2352x1568px; 45-degree field of view
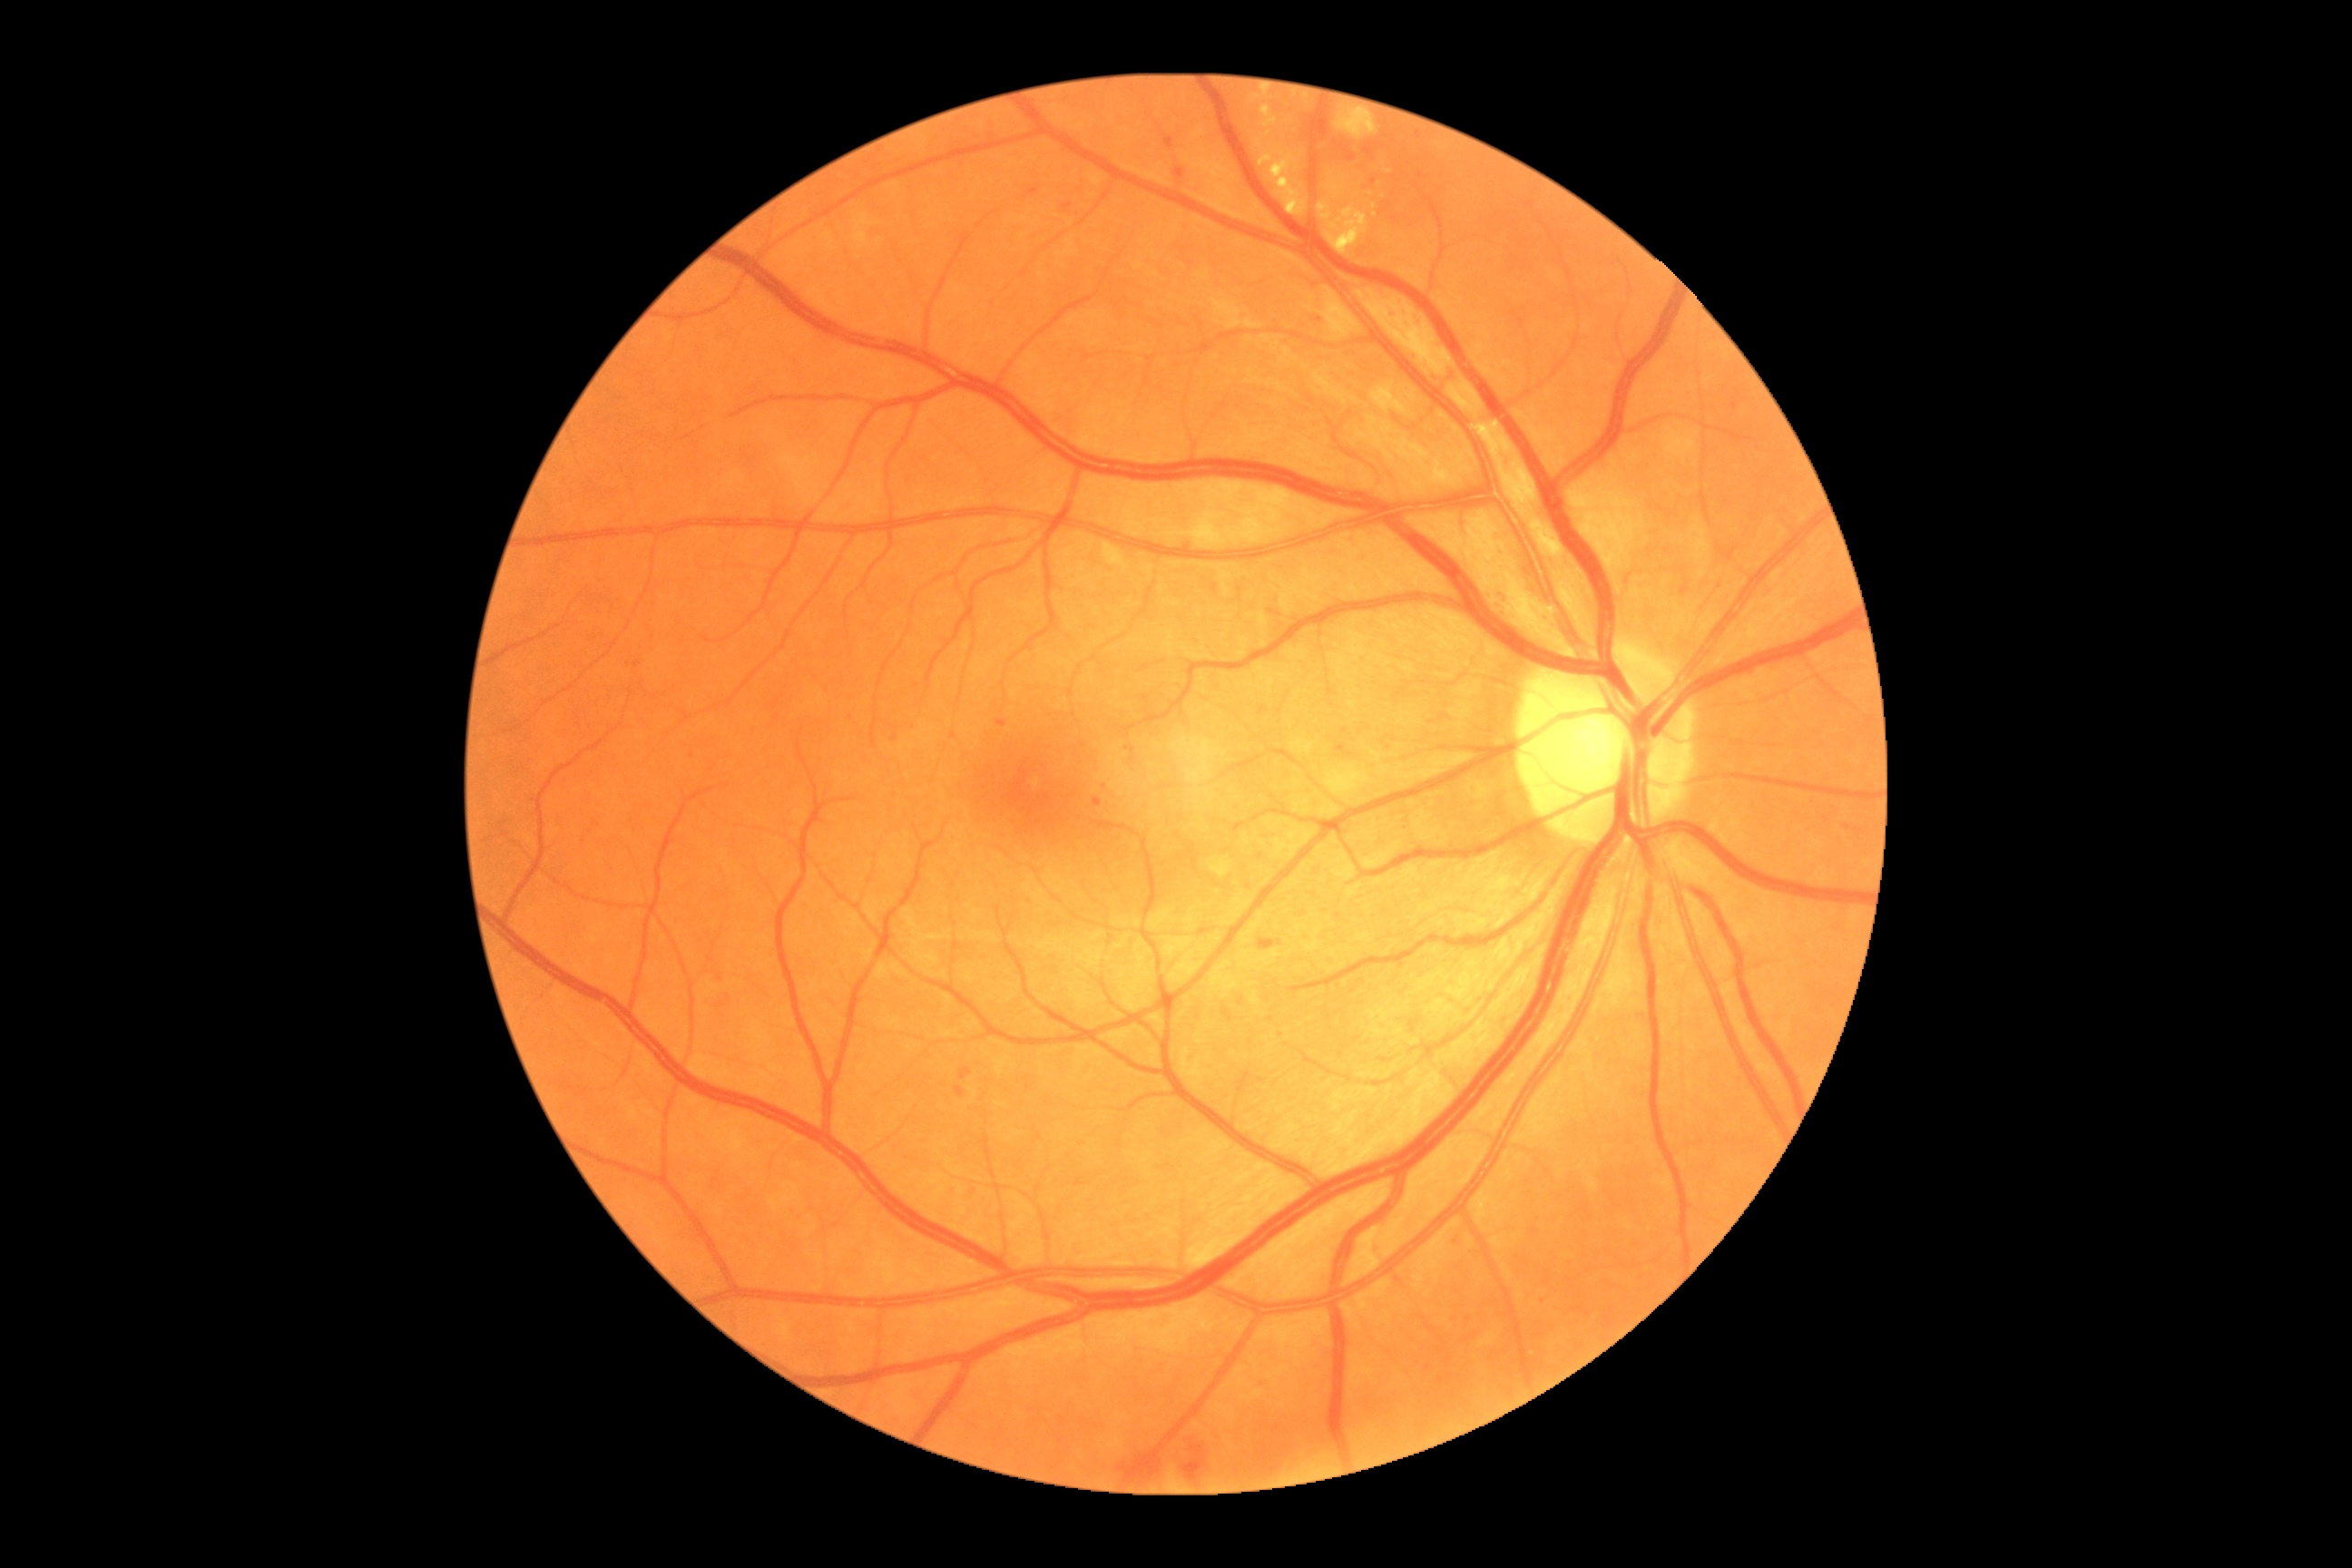 {"dr_category": "non-proliferative diabetic retinopathy", "dr_grade": "grade 2 (moderate NPDR)"}